Retinal fundus photograph
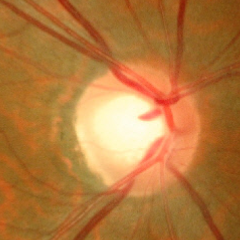
Glaucomatous changes are present. Demonstrates early glaucomatous optic neuropathy.